Image size 1659x2212; CFP.
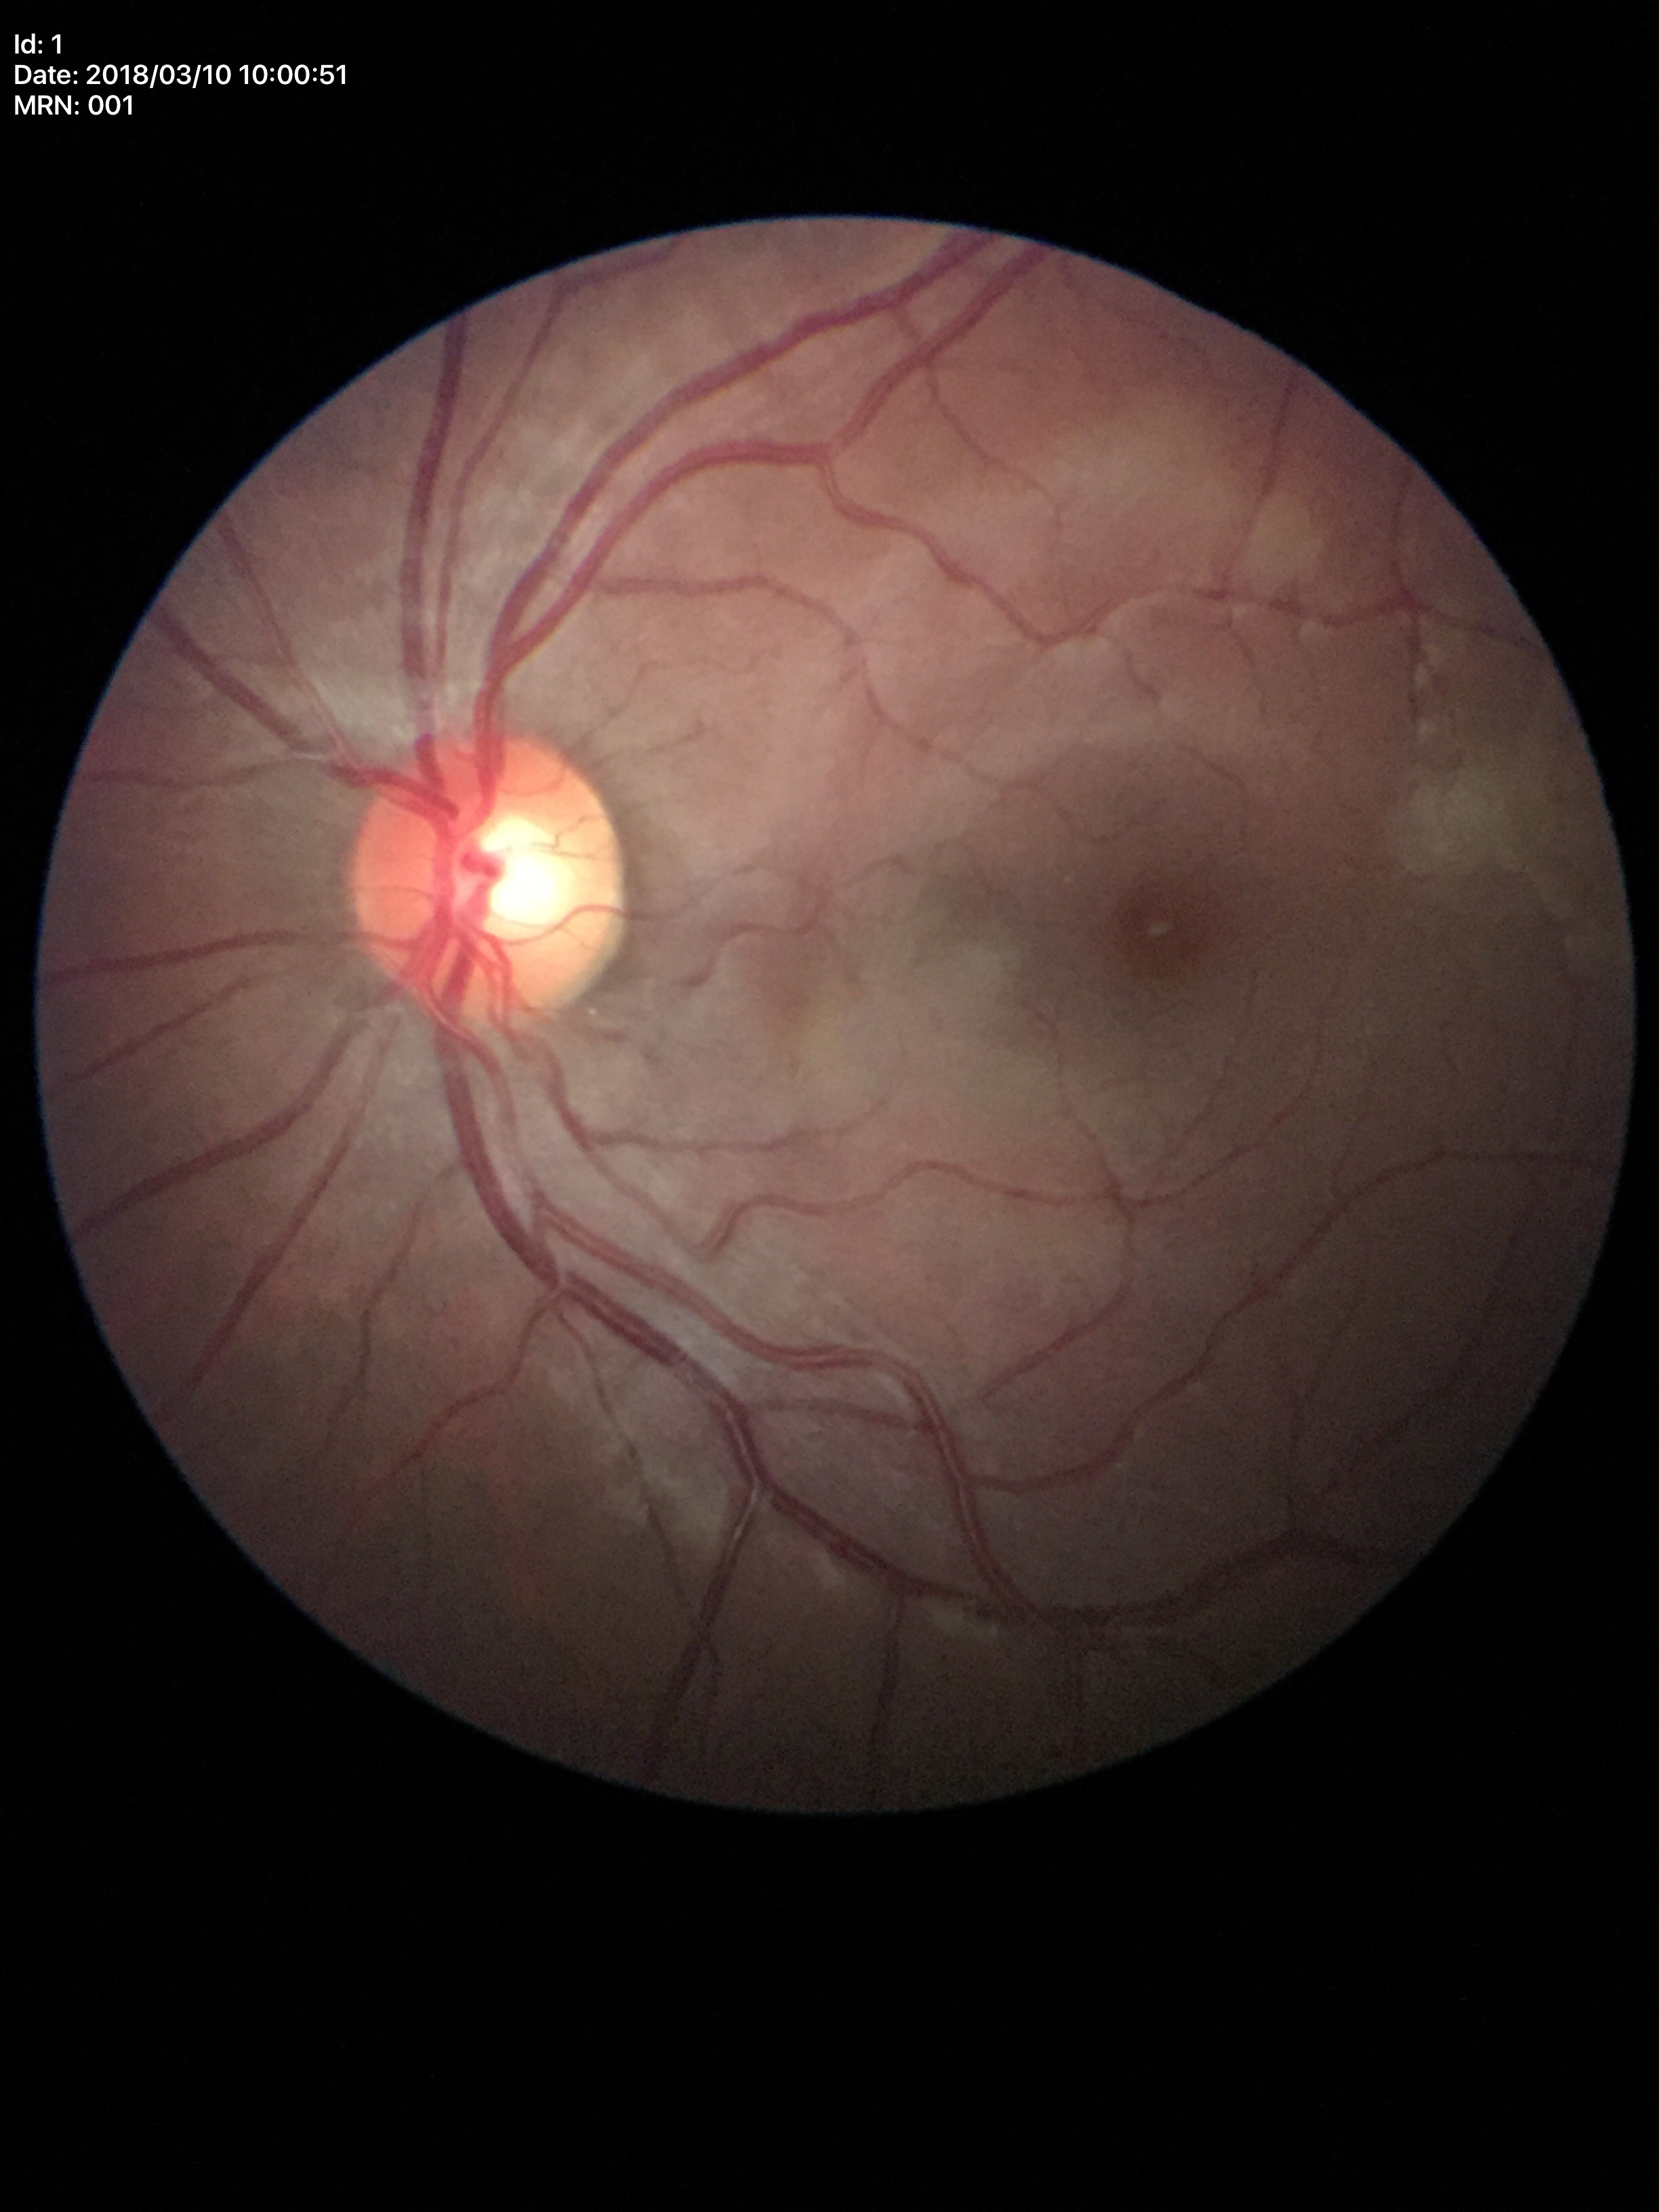 Glaucoma evaluation: not suspect.
Vertical C/D ratio (VCDR) of 0.49.
Area CDR (ACDR) is 0.26.